Ultra-widefield fundus mosaic — 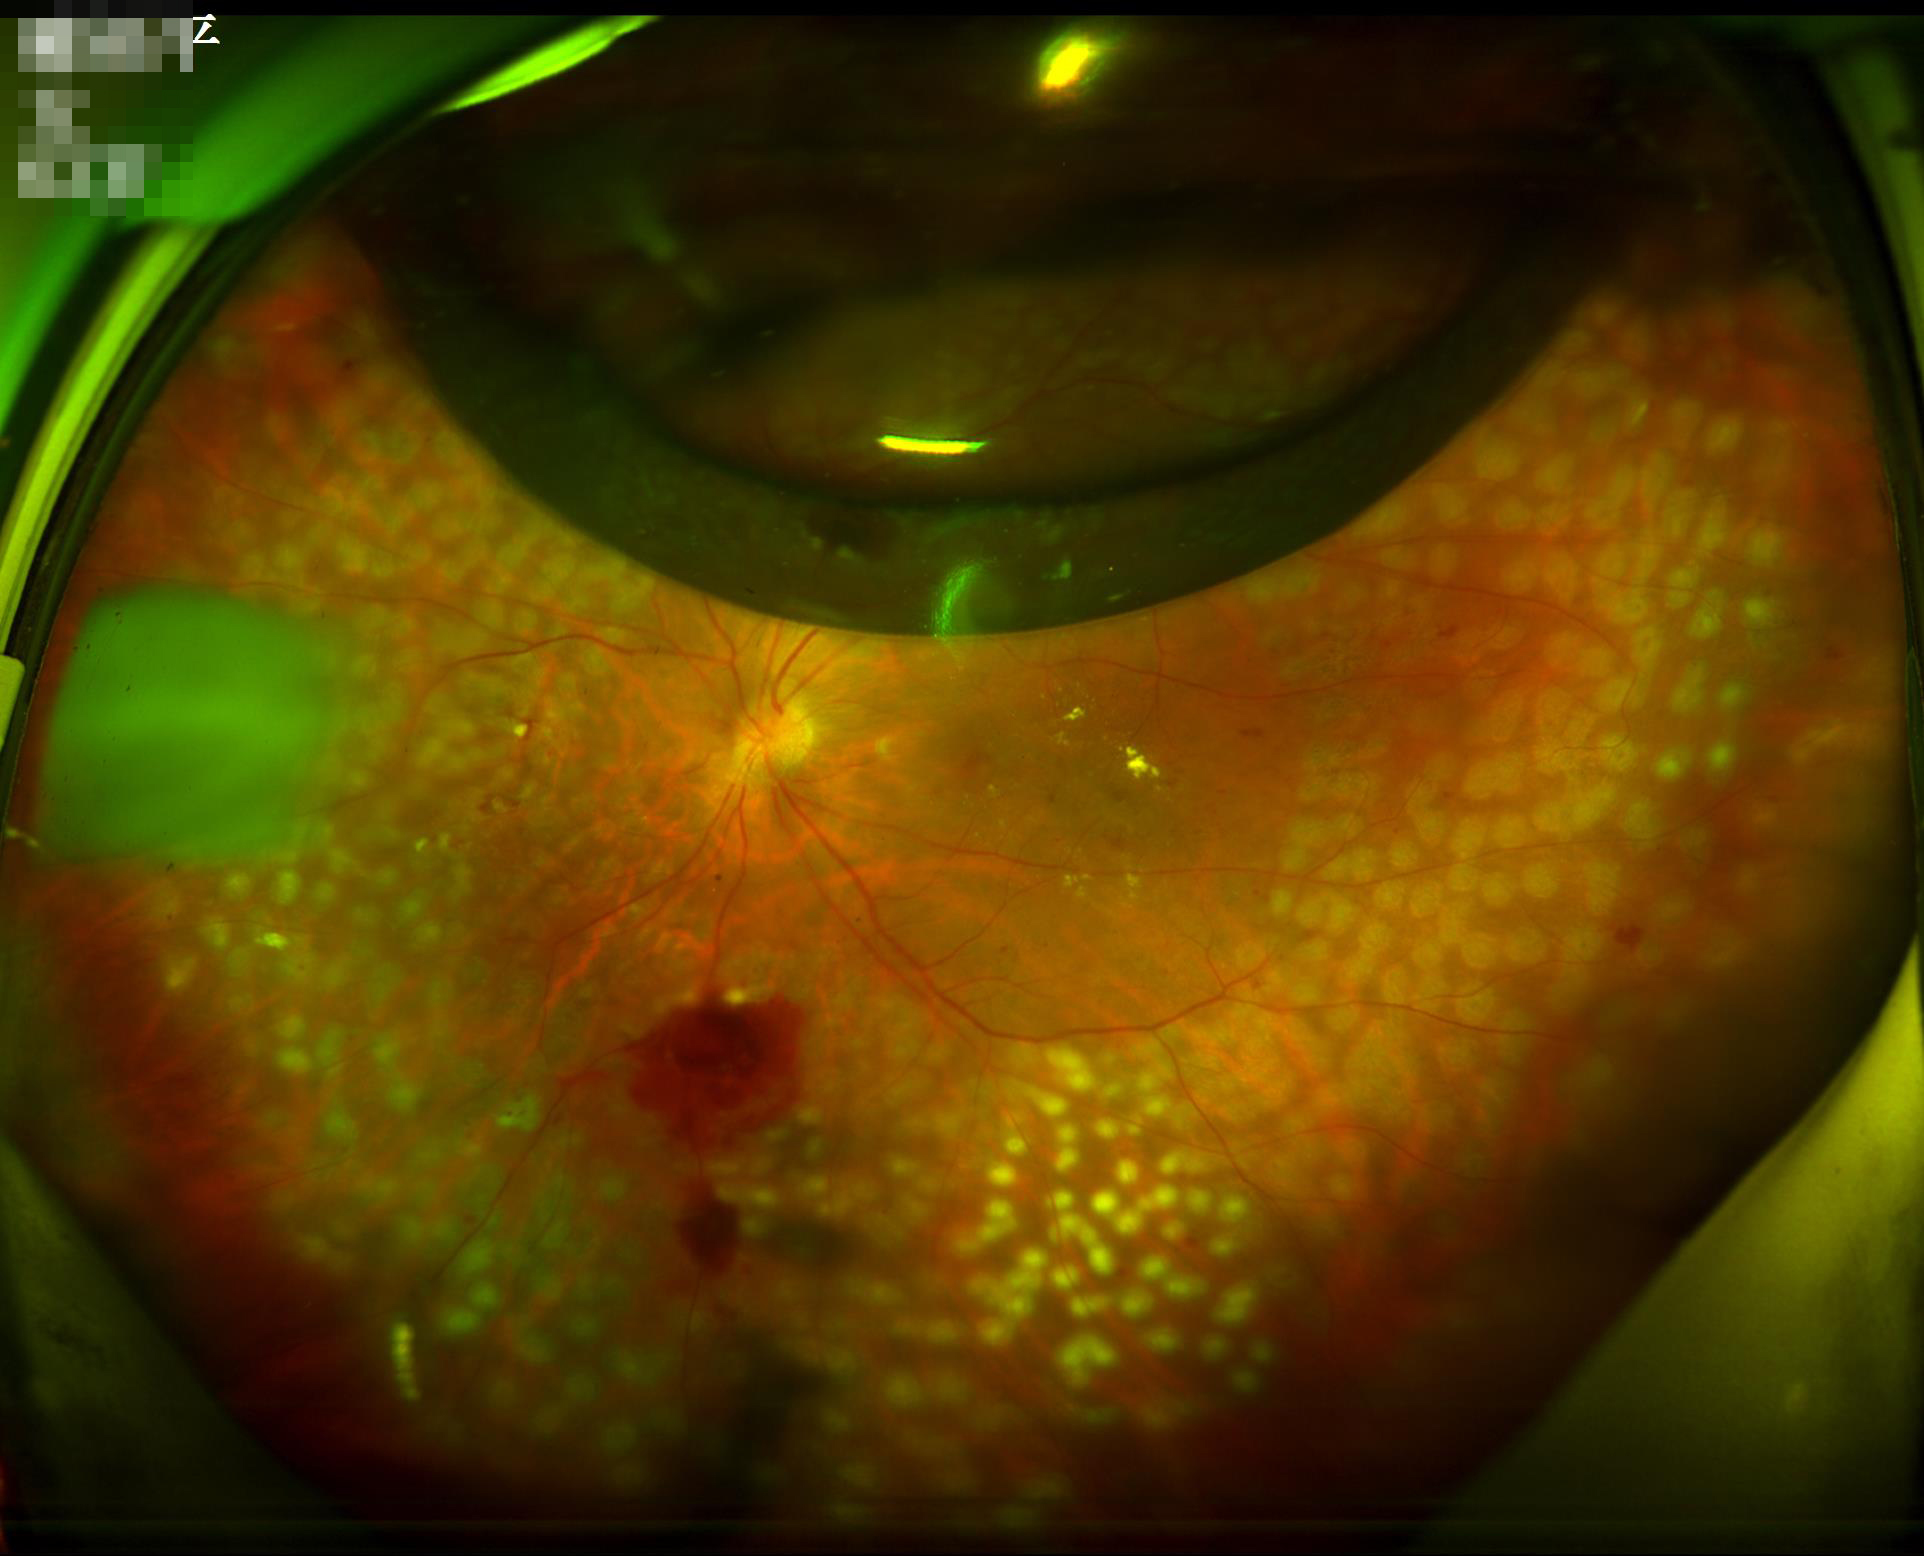 Quality grading: illumination/color: over- or under-exposed | contrast: wide intensity range, structures distinguishable | overall: poor, ungradable | sharpness: clear with no noticeable blur.